Pediatric retinal photograph (wide-field).
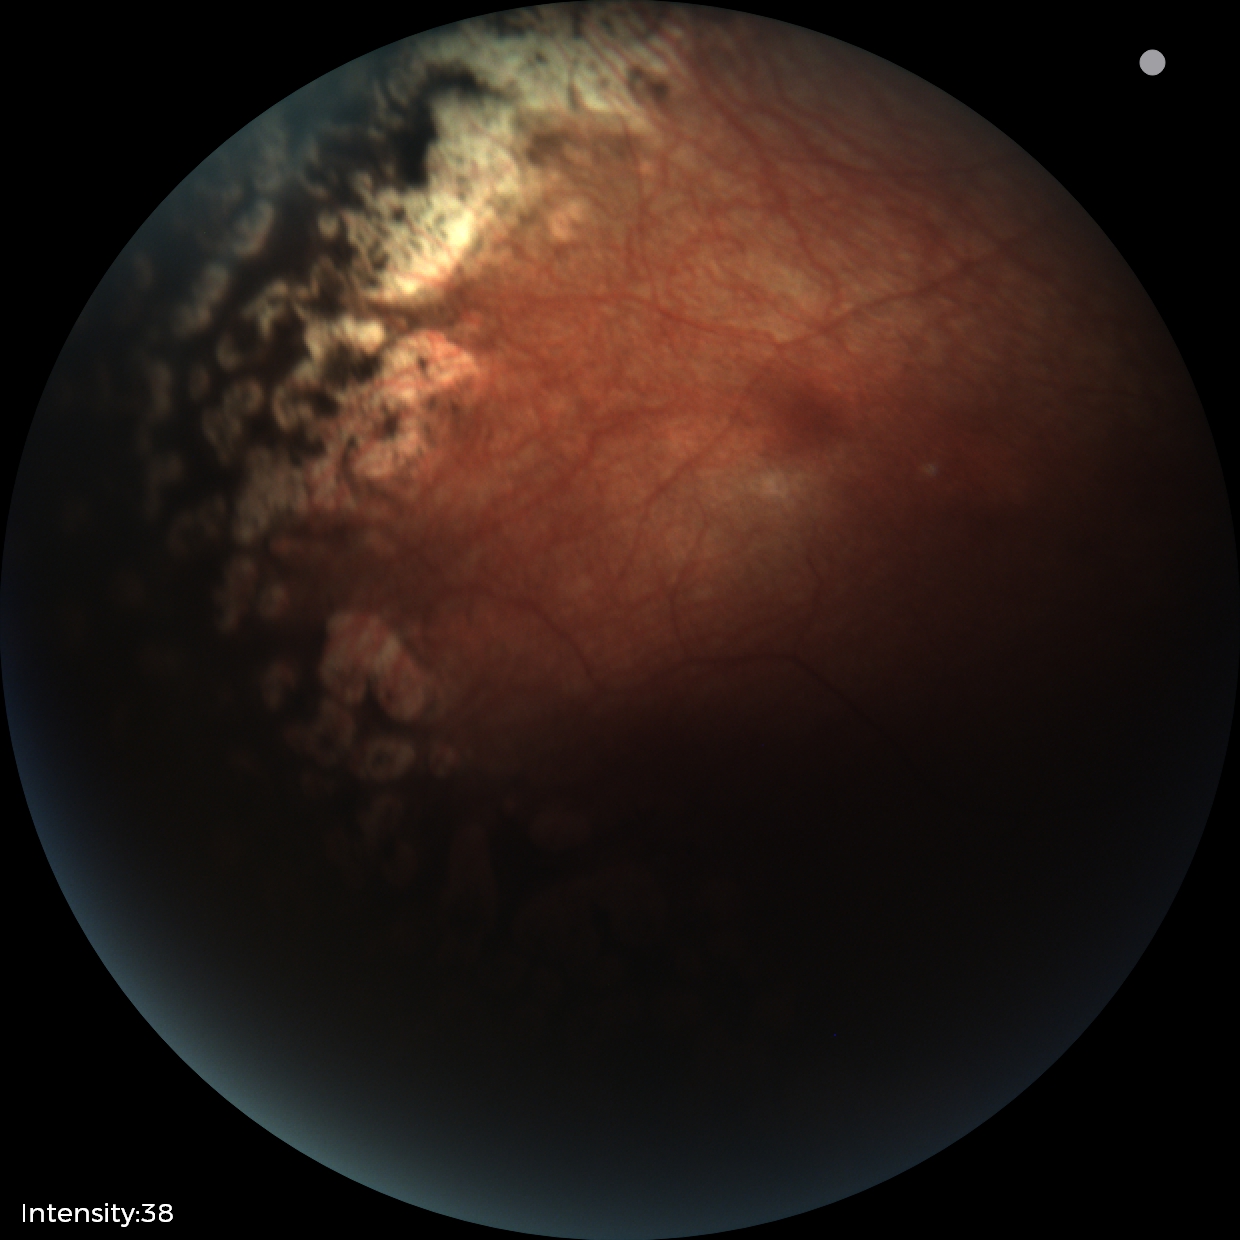

Screening diagnosis = status post ROP, plus disease = absent — posterior pole vessels without abnormal dilation or tortuosity.